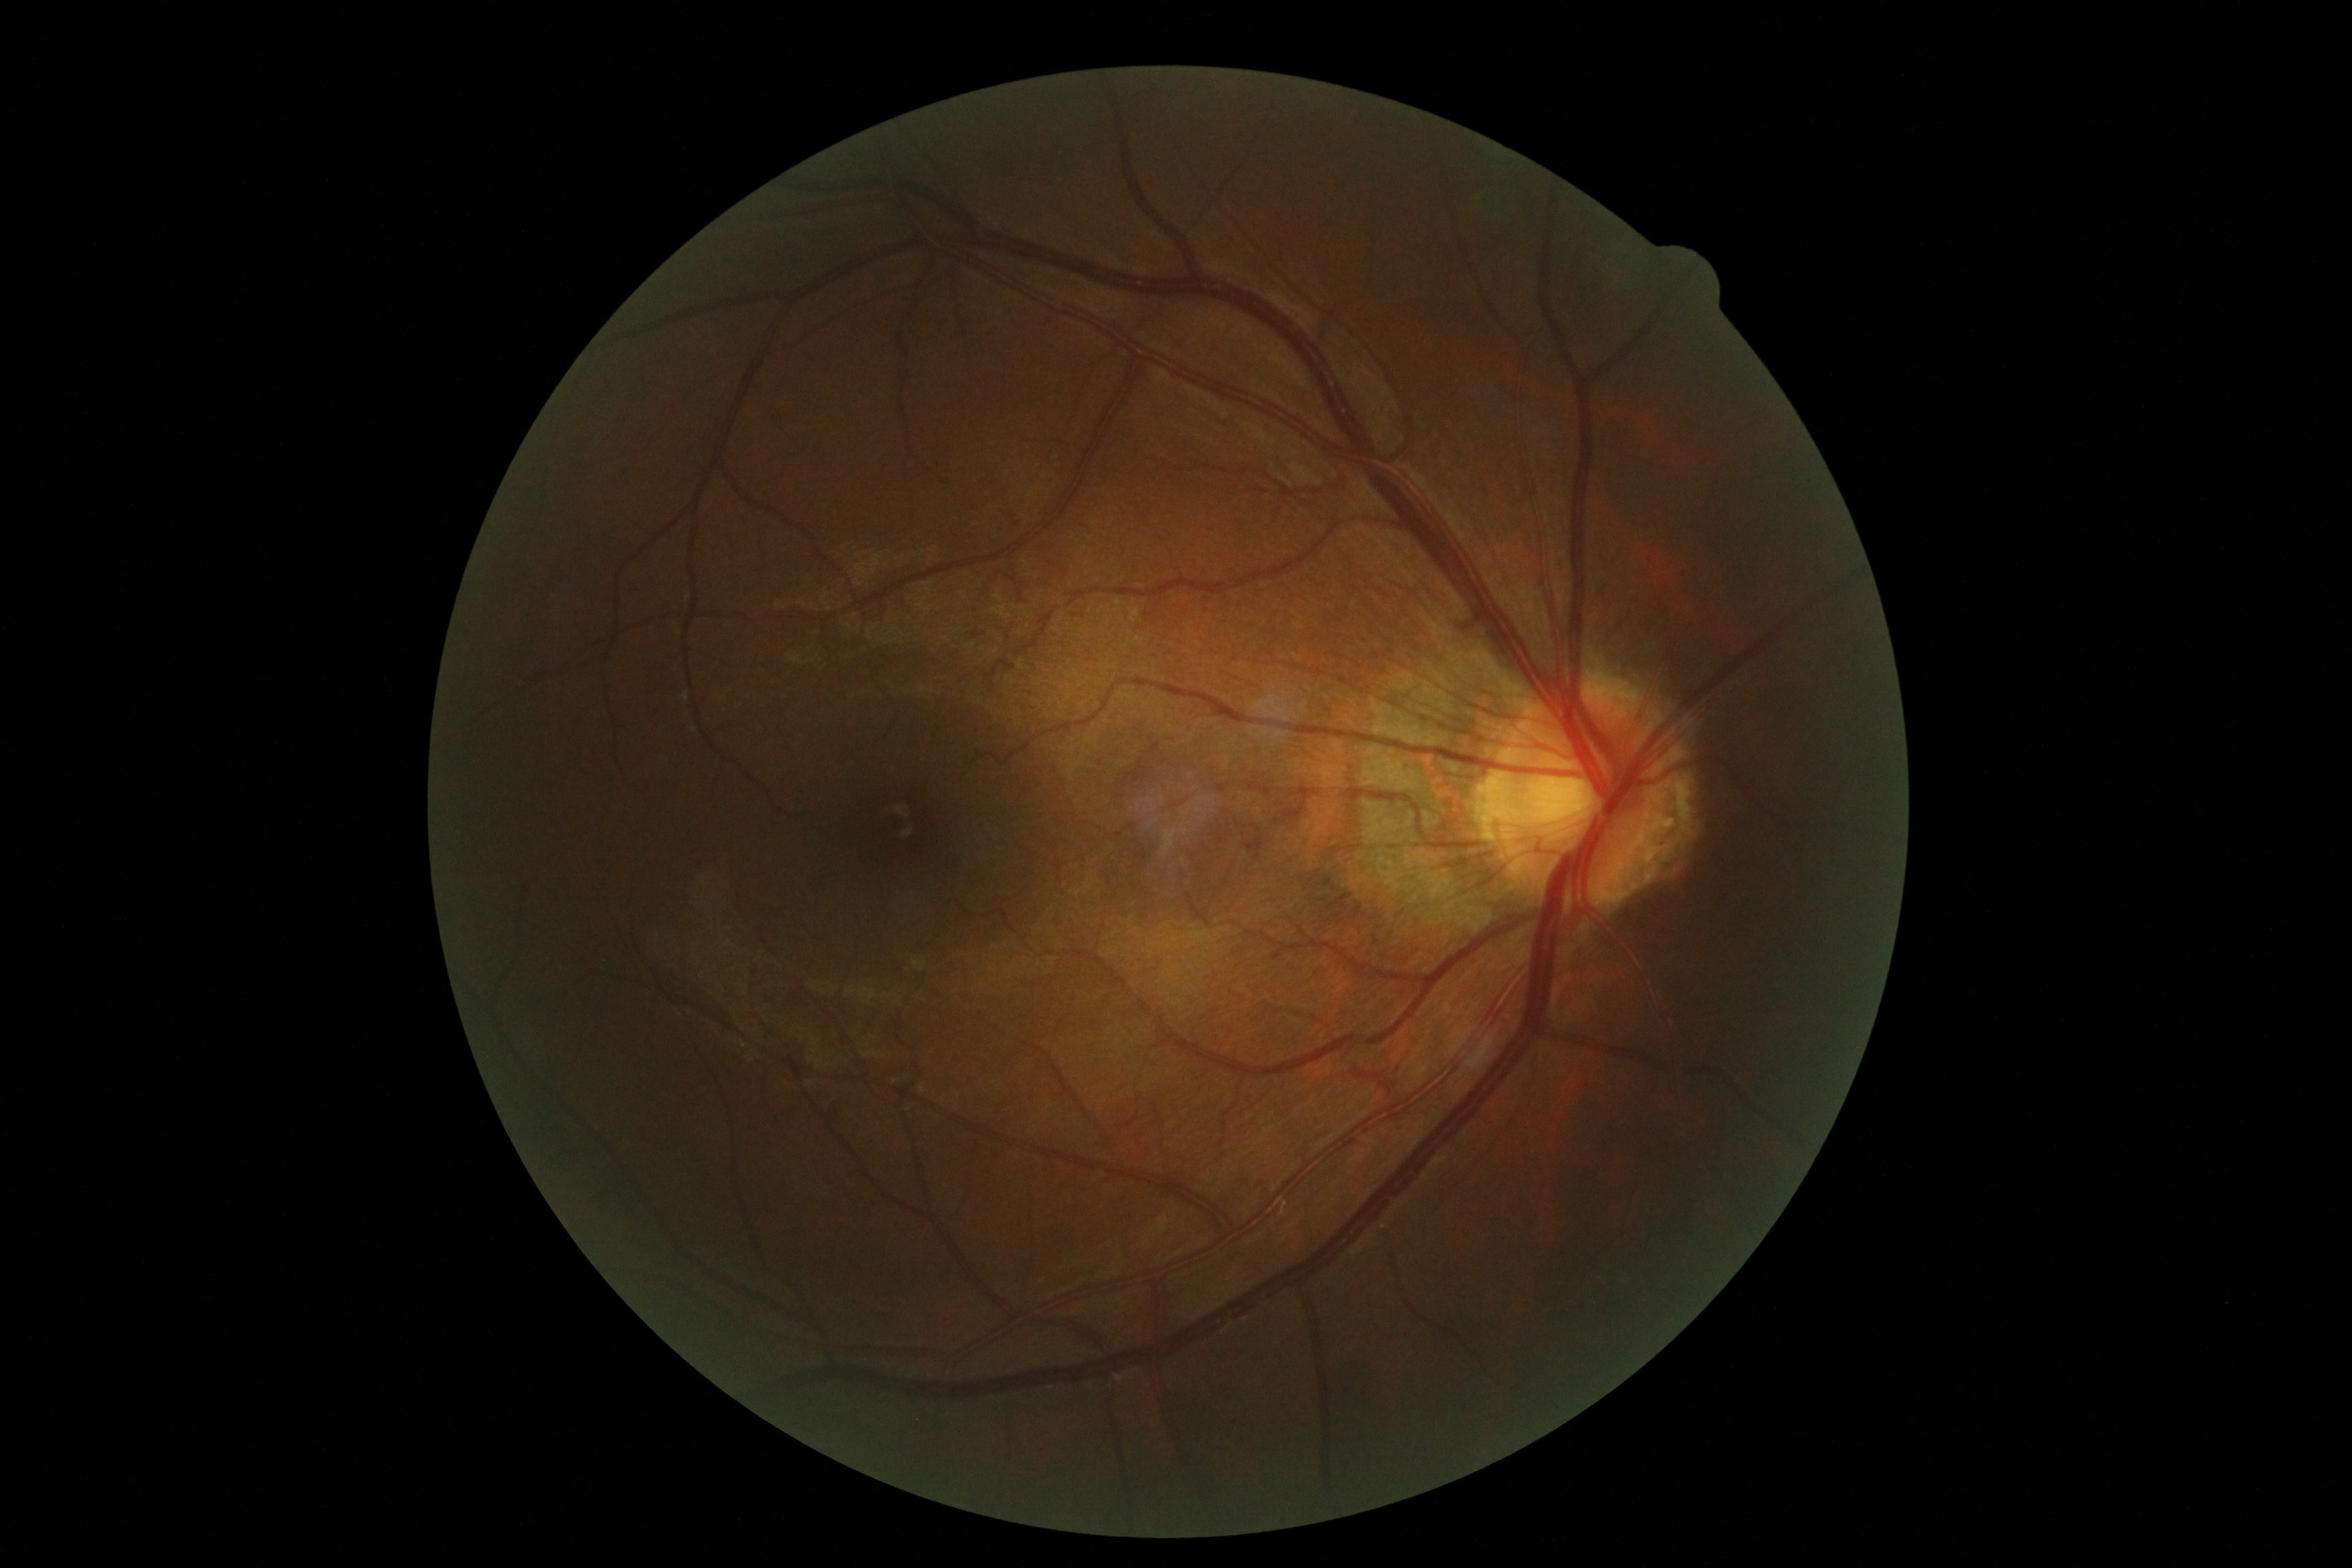
Annotations:
* DR impression — no DR findings
* diabetic retinopathy severity — 0